Modified Davis grading, no pharmacologic dilation:
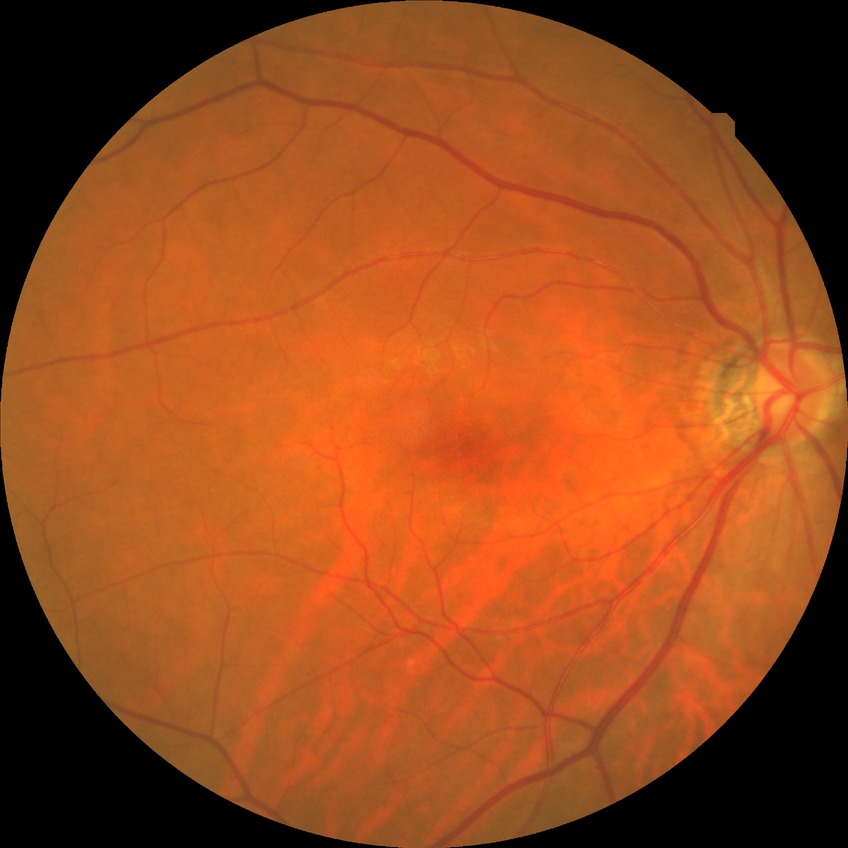
Diabetic retinopathy severity: no diabetic retinopathy.